Image size 412x310 · 45° FOV:
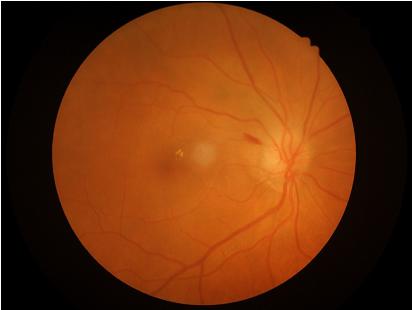 The image is clear. No over- or under-exposure.